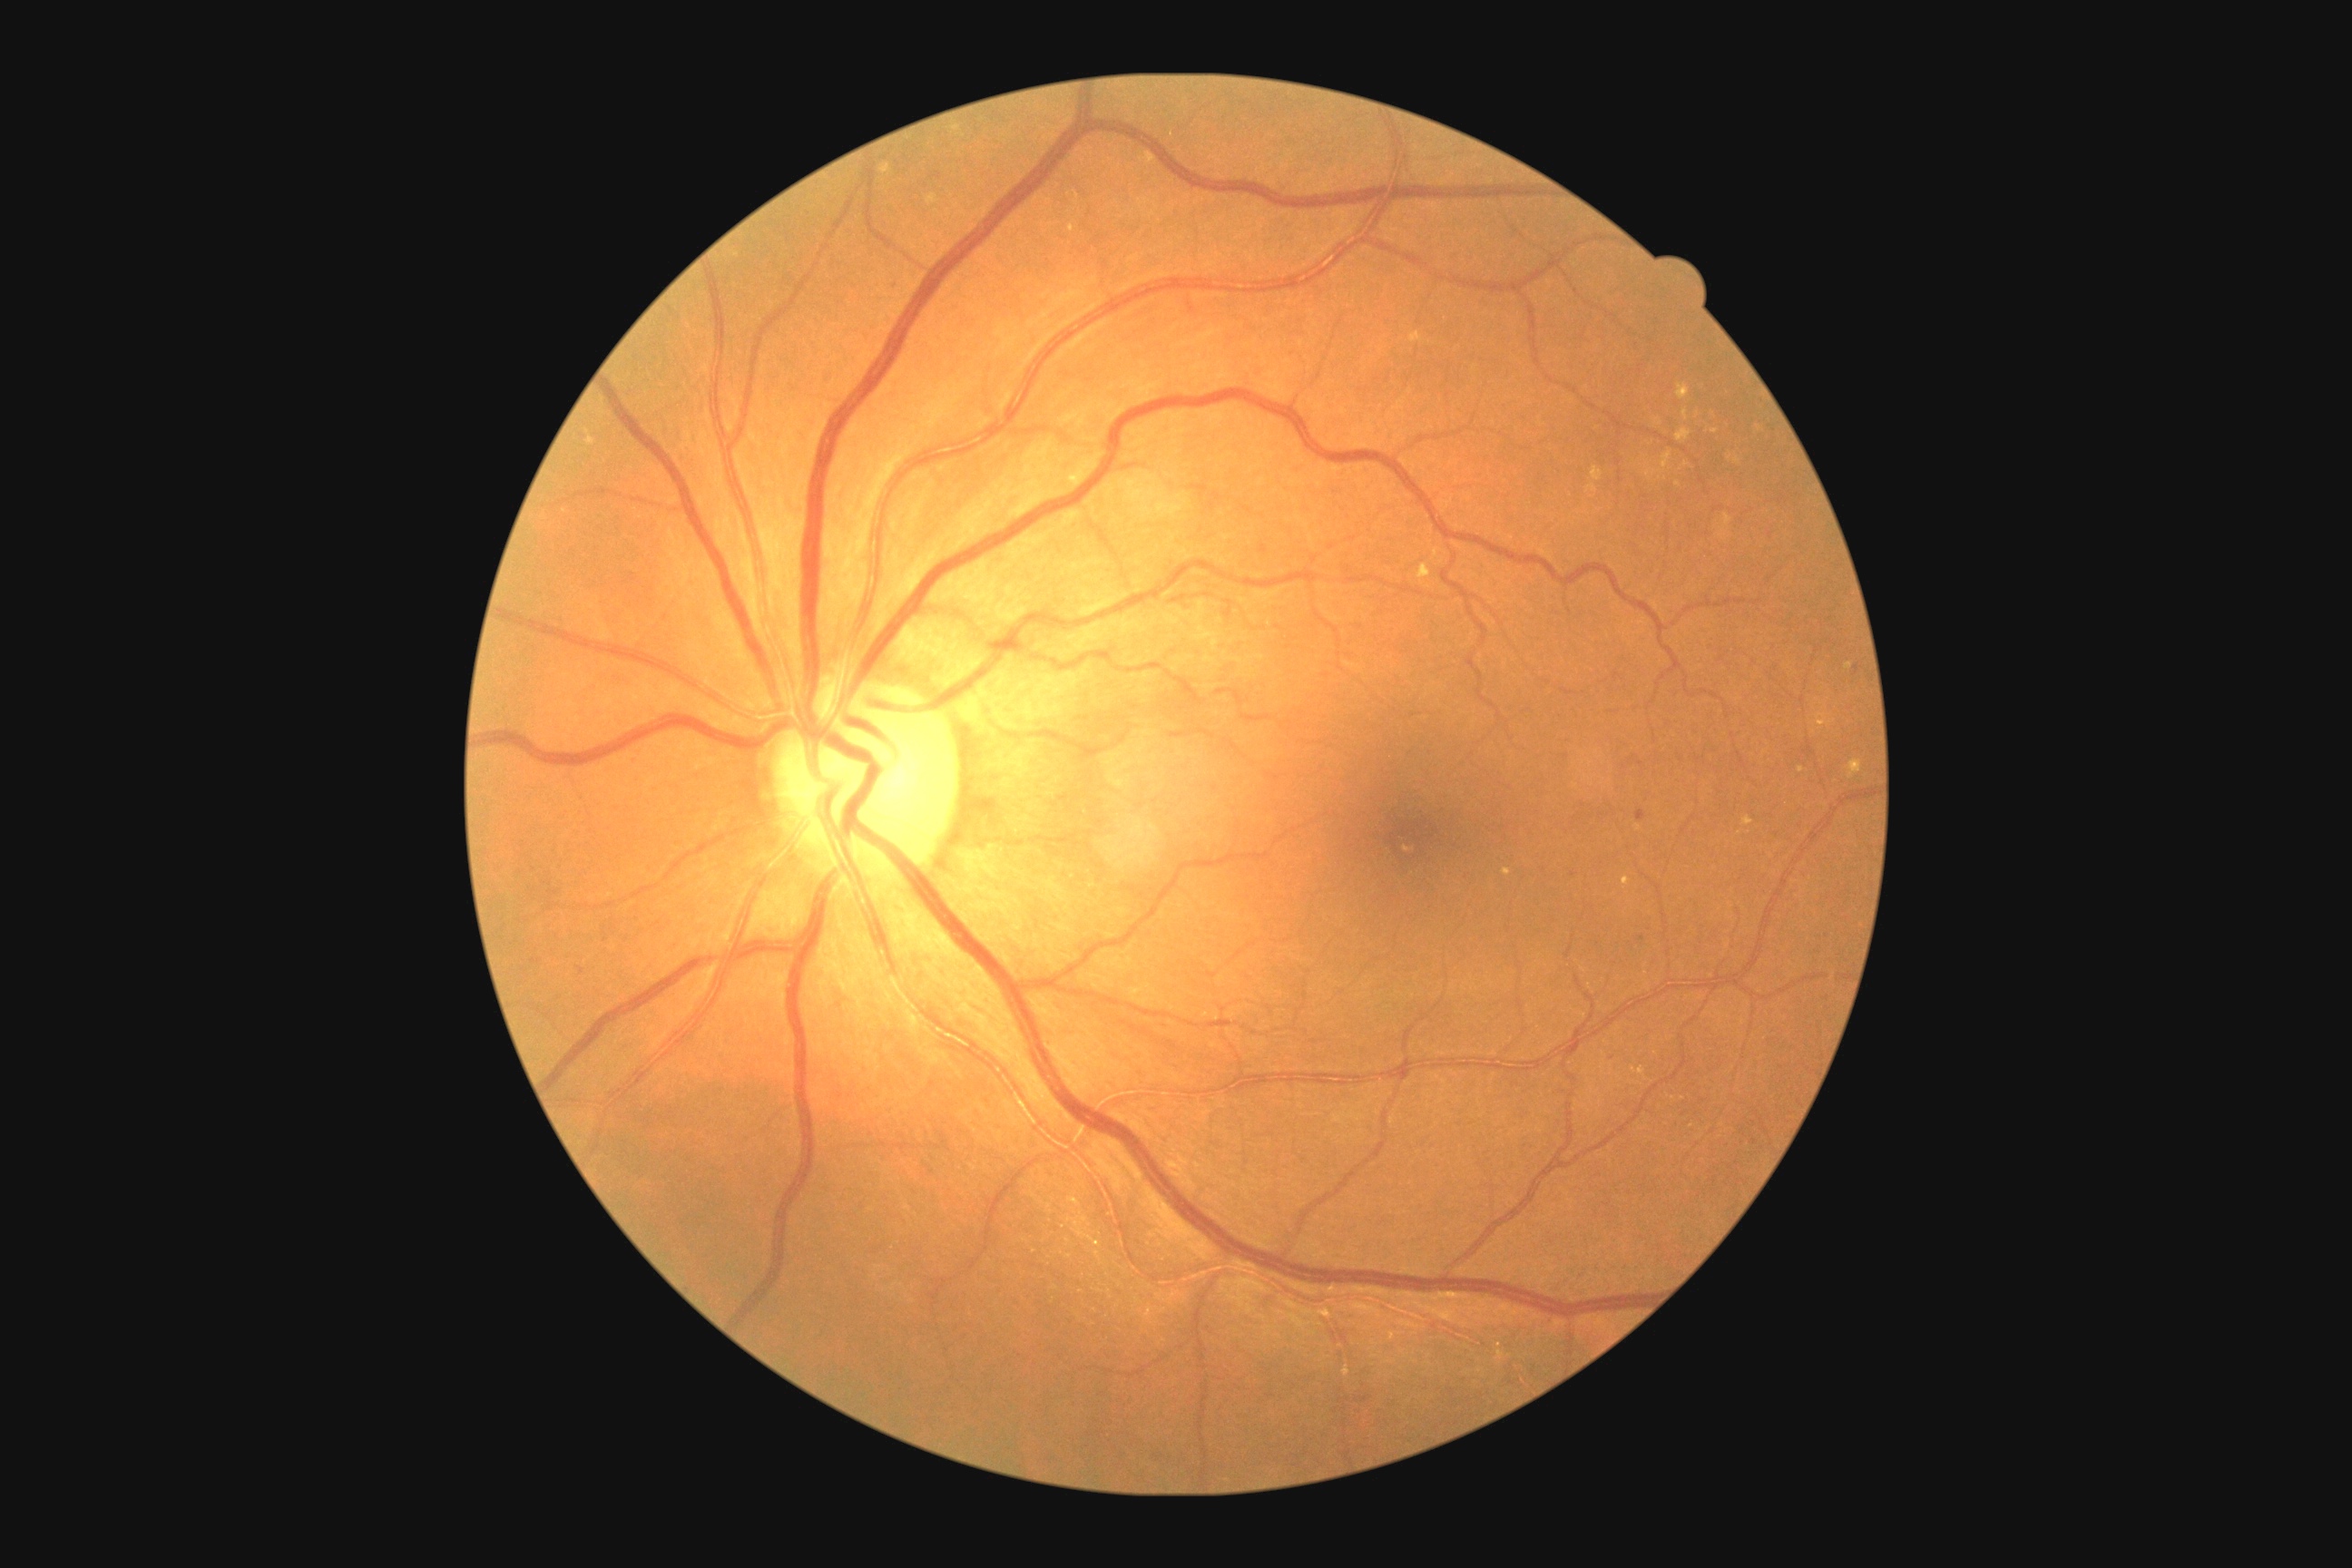

DR stage is moderate NPDR (grade 2) — more than just microaneurysms but less than severe NPDR
Selected lesions:
* HEs: none identified
* MAs (subset): 1636,810,1647,823; 533,959,542,963; 576,966,585,974
* MAs (small, approximate centers) near pt(1643, 938)
* SEs: none identified
* EXs (subset): 1743,816,1754,827; 1504,868,1511,876; 952,124,961,132; 1847,663,1852,671; 1654,418,1663,426; 587,436,596,446; 1712,429,1720,435; 1070,224,1075,233; 1720,529,1729,540; 1847,760,1863,779; 1631,1068,1645,1075; 1816,714,1834,727; 1661,451,1672,469; 879,164,892,175; 1418,564,1431,580
* EXs (small, approximate centers) near pt(1683, 1099); pt(1759, 428); pt(1686, 464)